Diabetic retinopathy graded by the modified Davis classification — 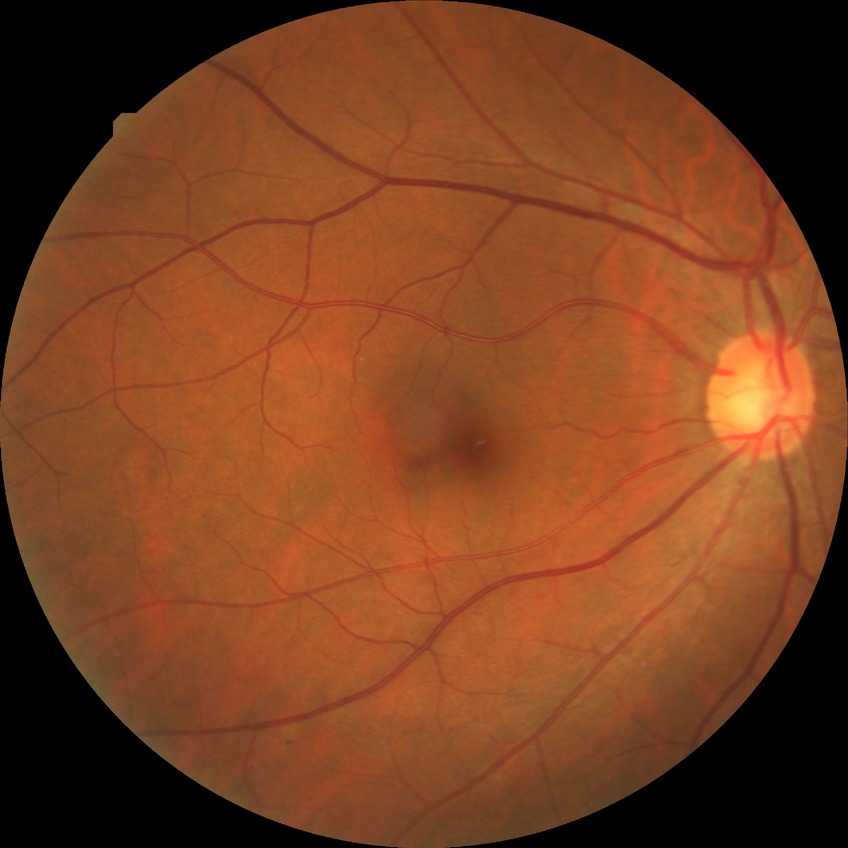

modified Davis grading = simple diabetic retinopathy.